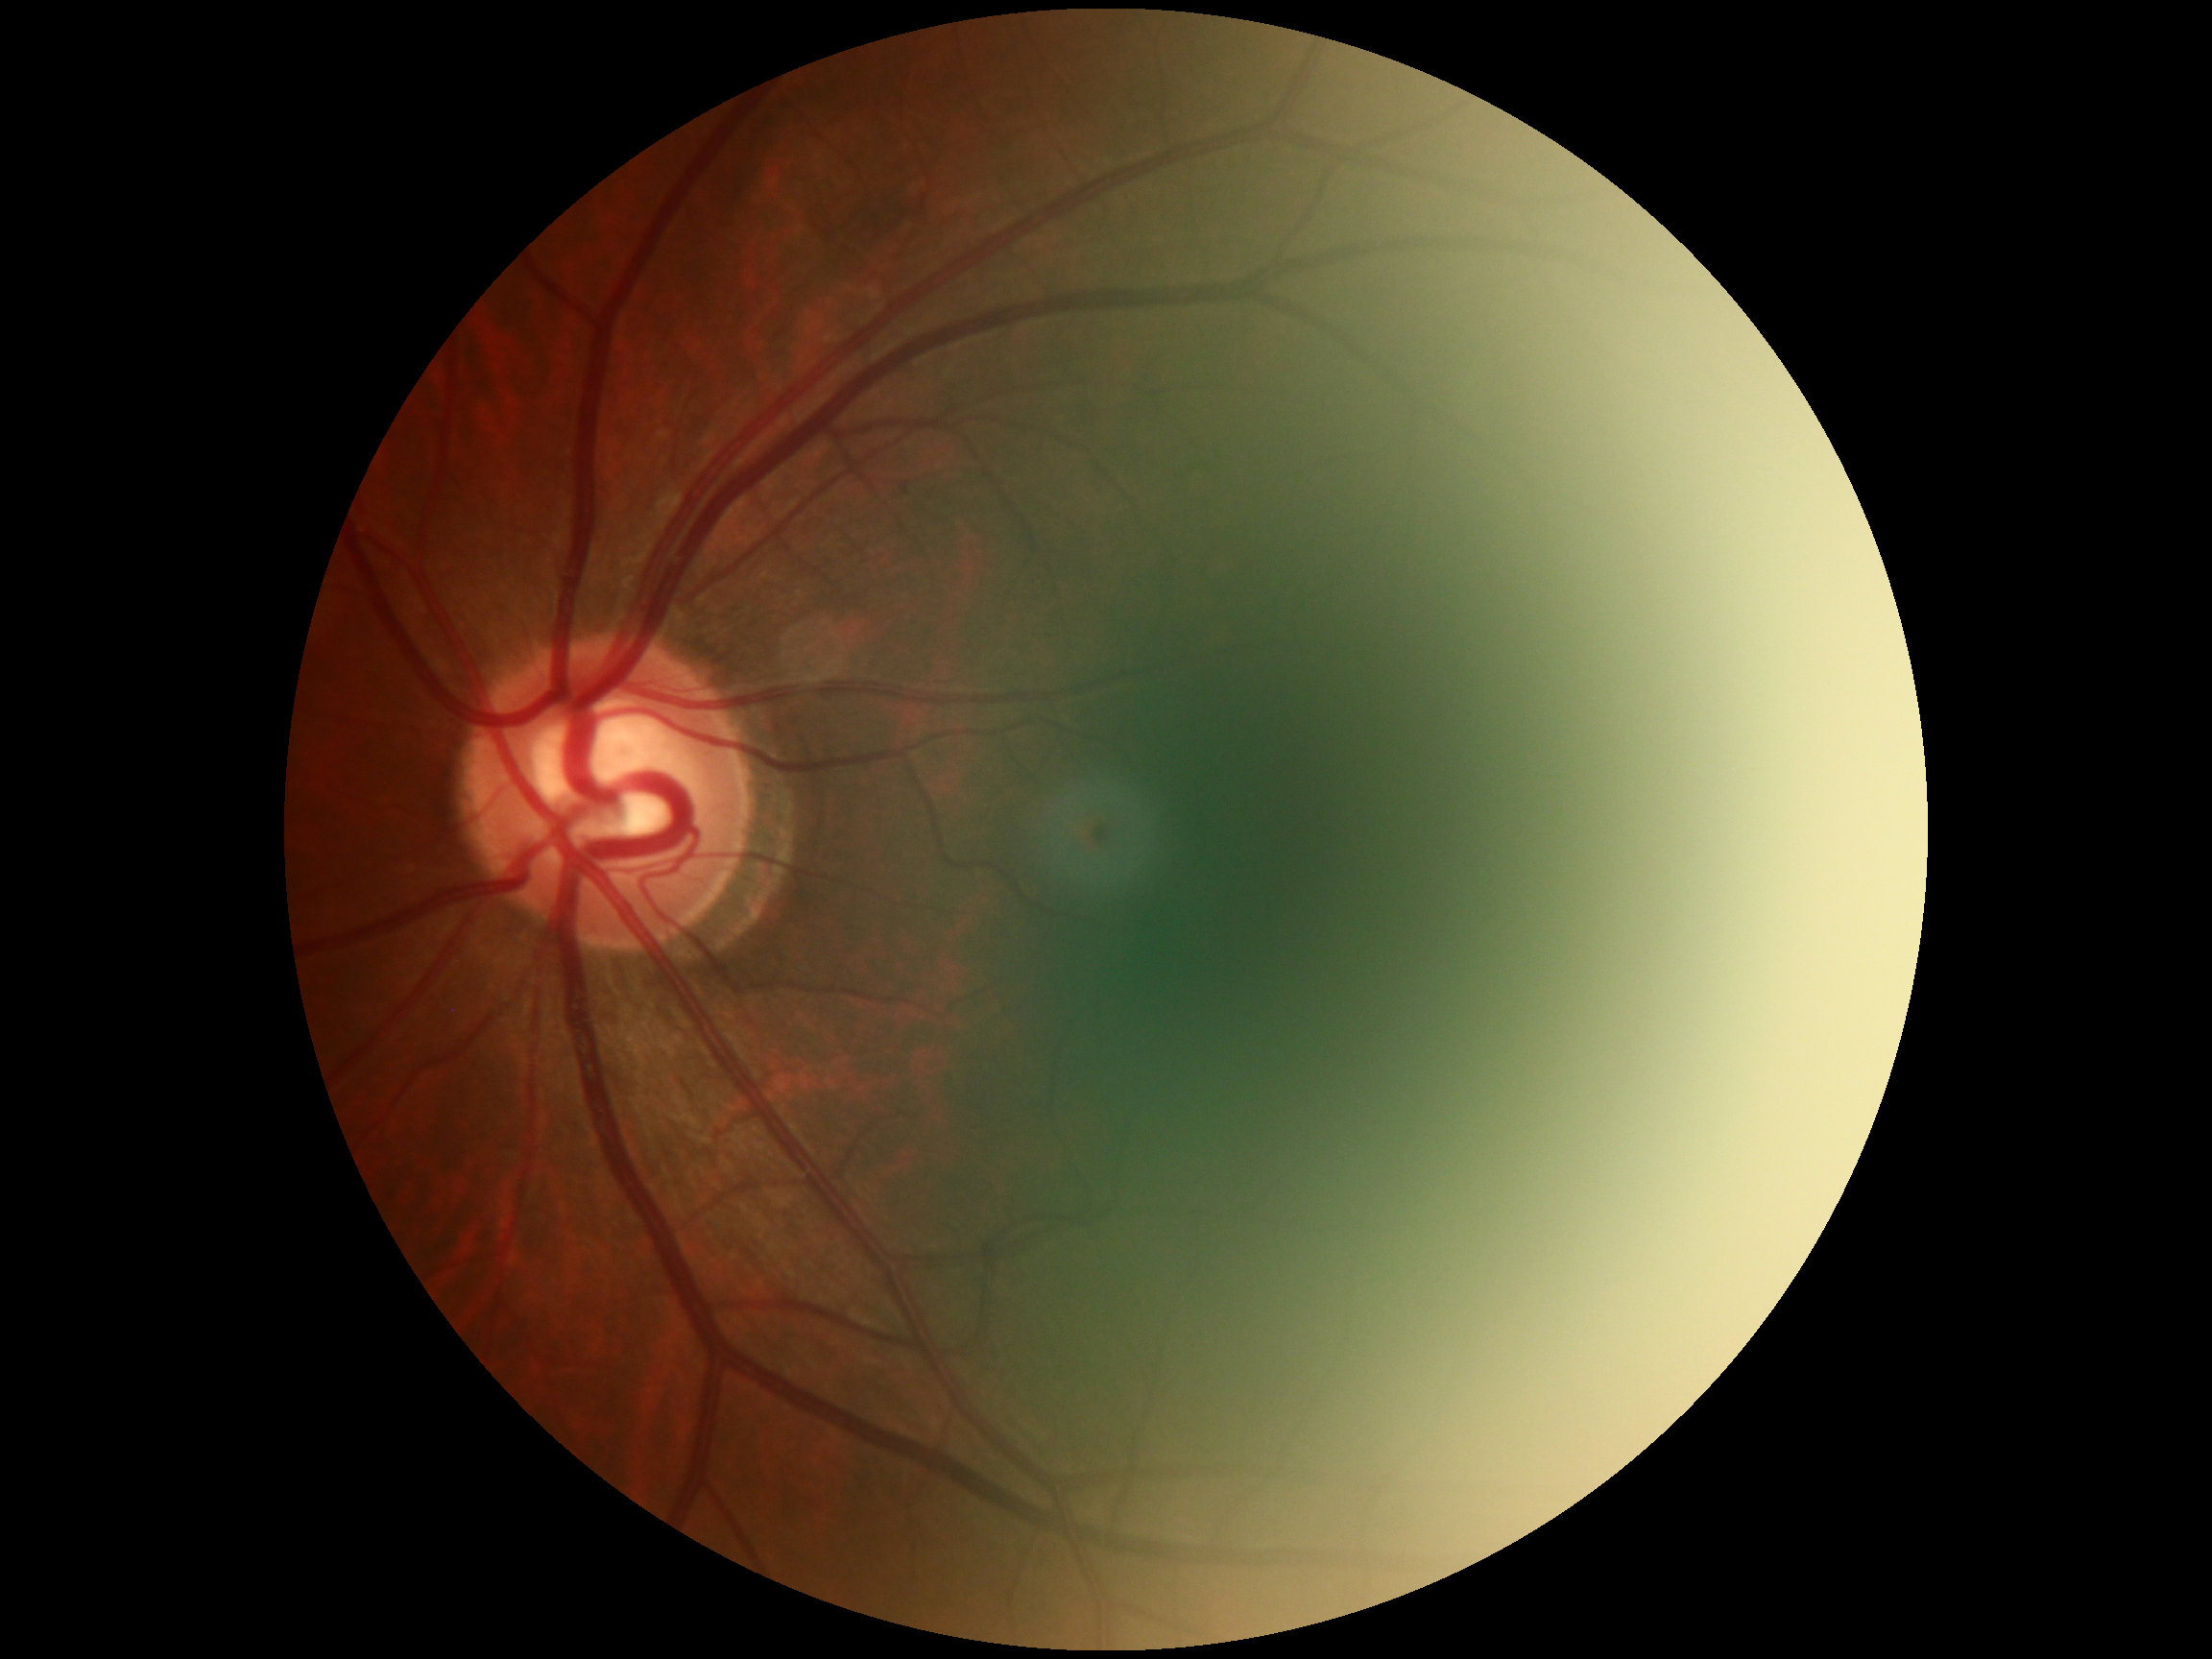
DR impression = negative for DR, DR stage = grade 0 (no apparent retinopathy) — no visible signs of diabetic retinopathy.